Wide-field fundus photograph of an infant · 100° field of view (Phoenix ICON):
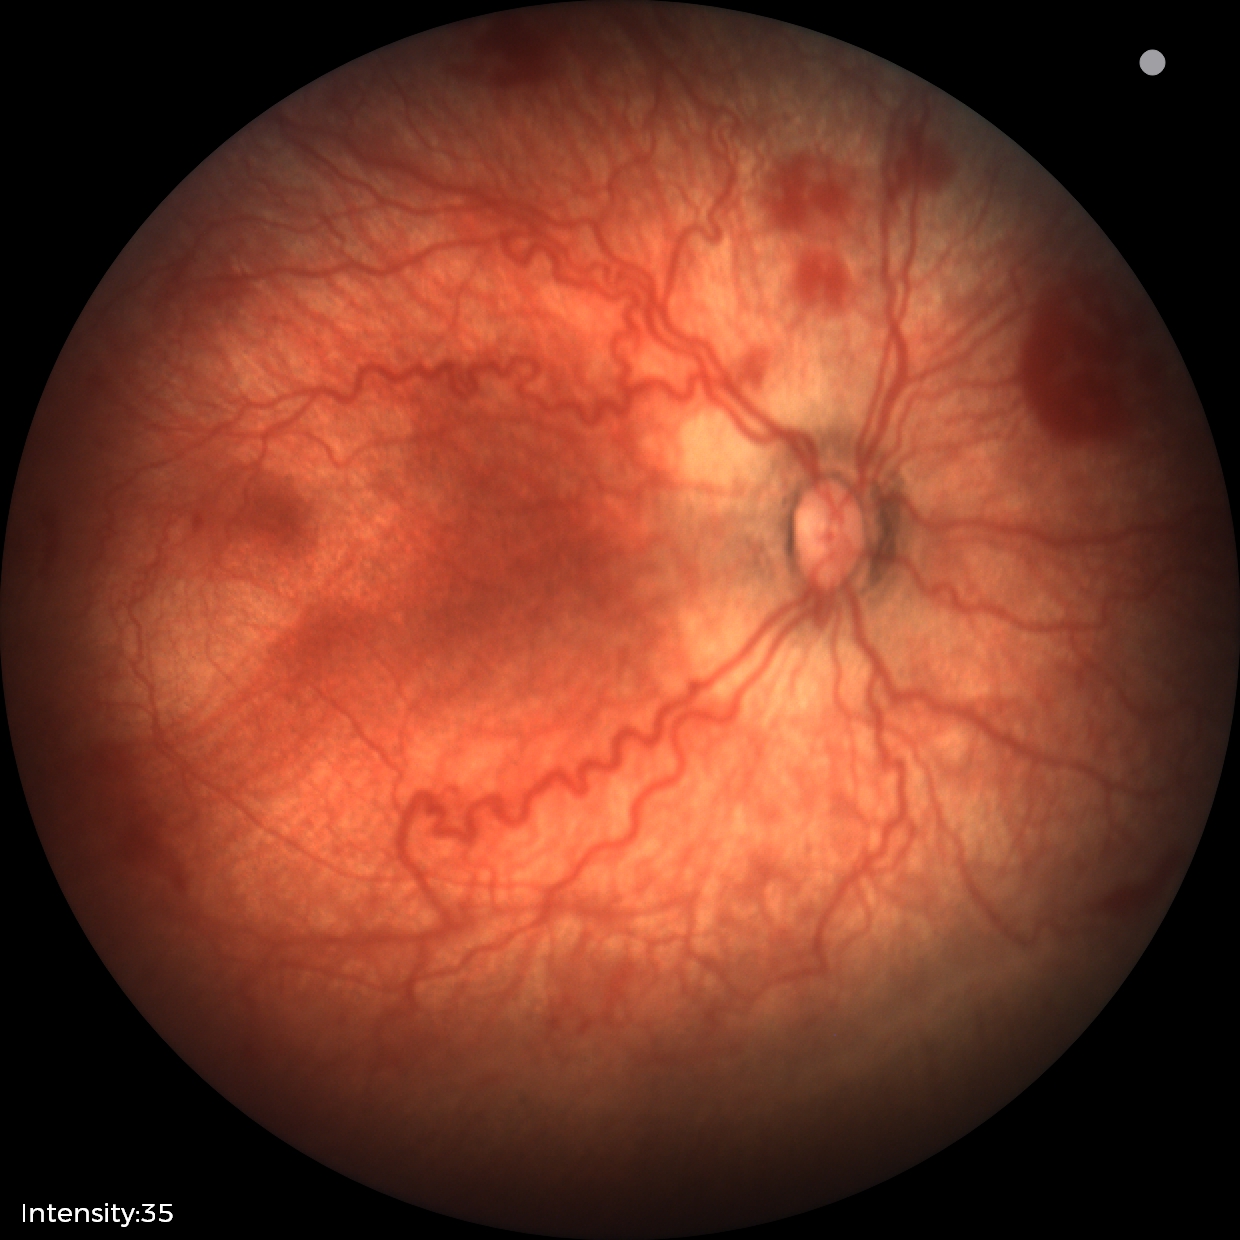

Assessment: plus disease; retinopathy of prematurity stage 2 — ridge with height and width at the demarcation line.